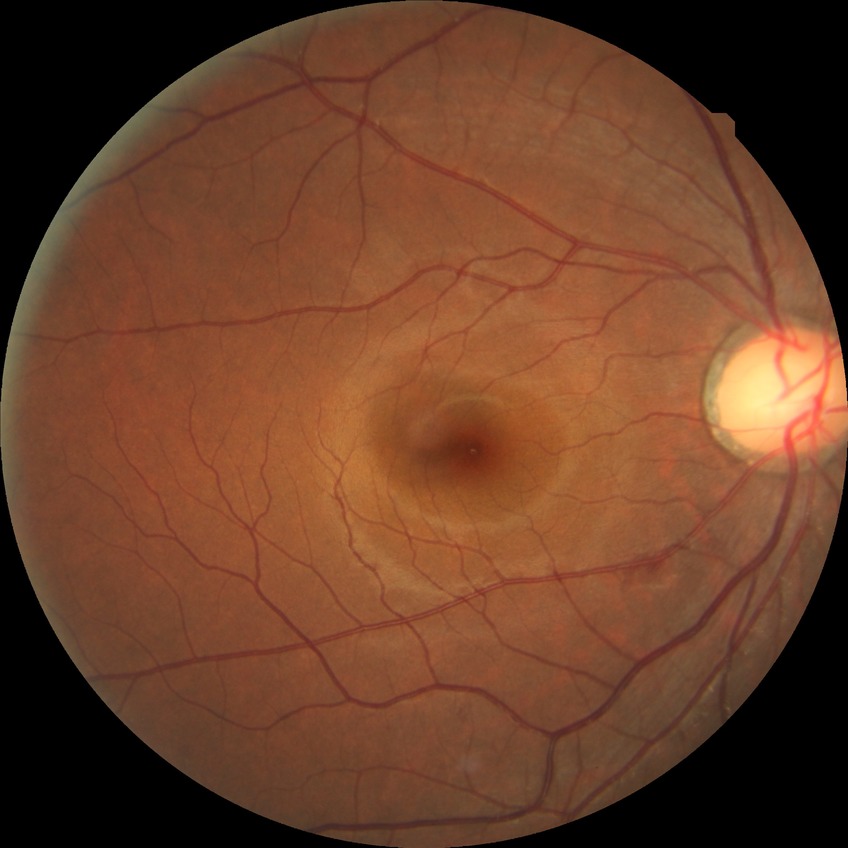

retinopathy stage = no diabetic retinopathy